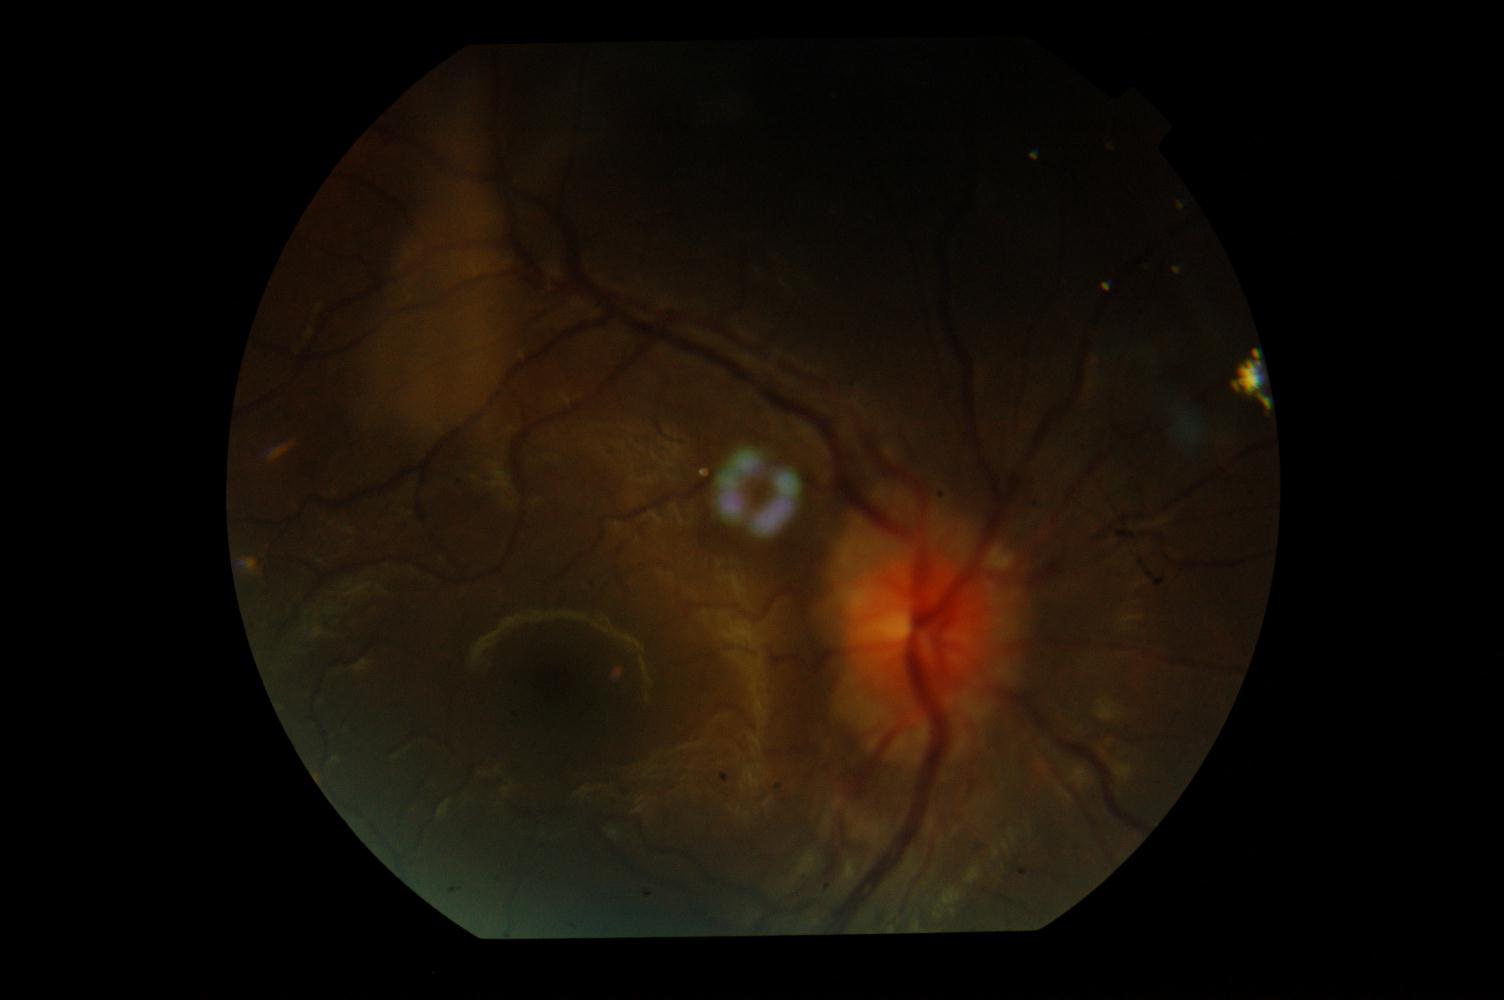 This fundus photograph shows idiopathic intracranial hypertension.